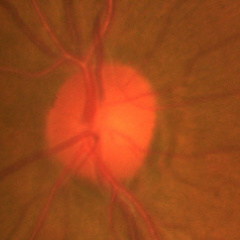

Color fundus photograph showing early glaucomatous optic neuropathy.